Infant wide-field retinal image — 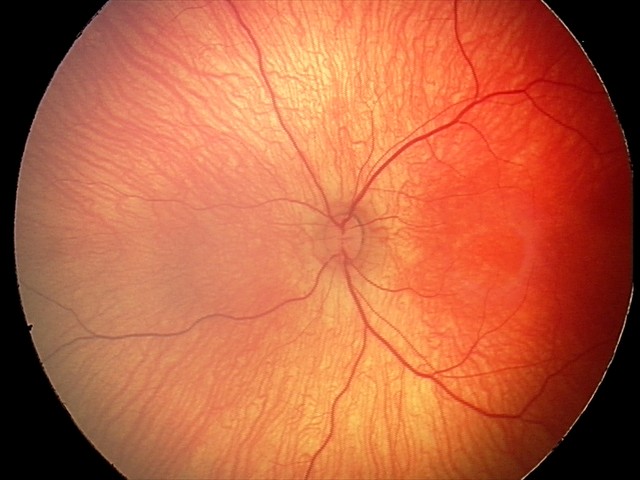 Normal screening examination.